Infant wide-field fundus photograph:
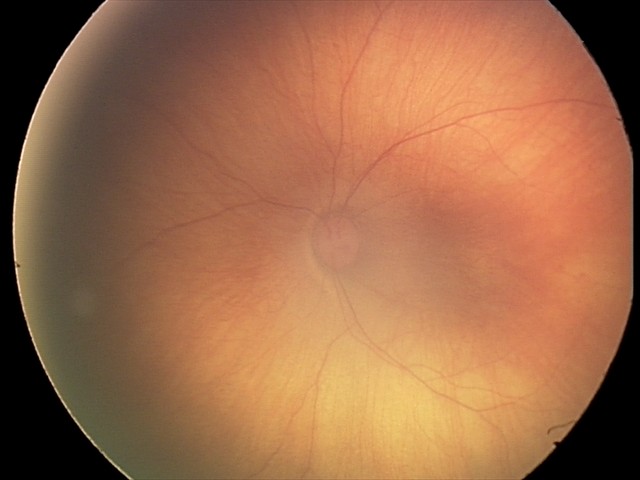 Diagnosis from this screening exam: retinal hemorrhages.